NIDEK AFC-230 fundus camera, 848 x 848 pixels — 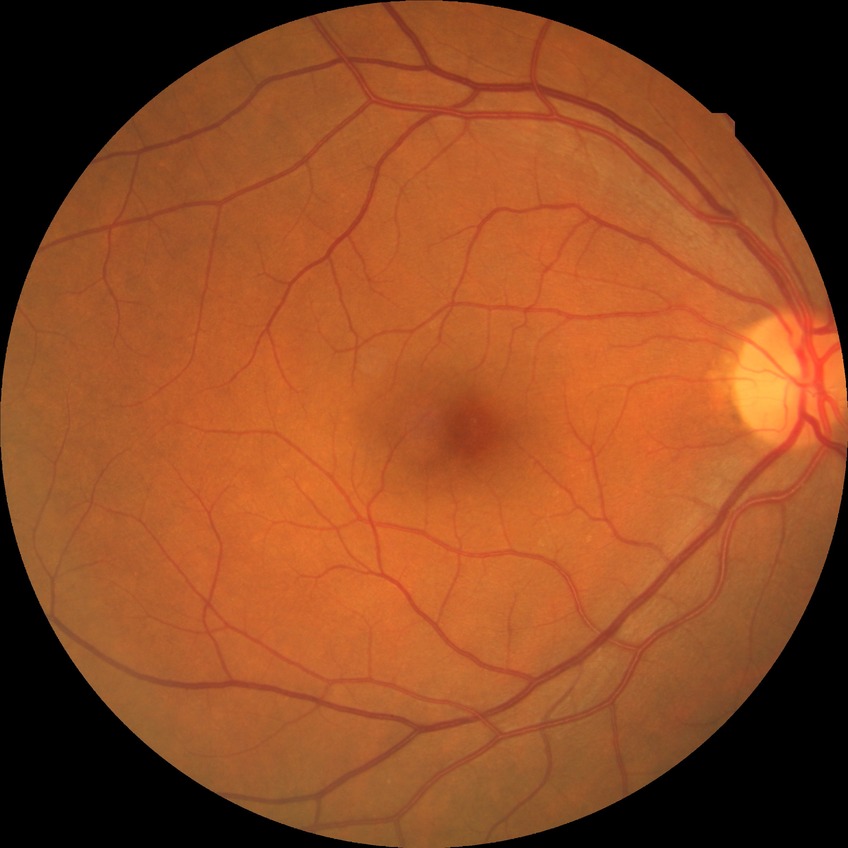
Davis grade: NDR; DR impression: negative for DR.